2352 by 1568 pixels
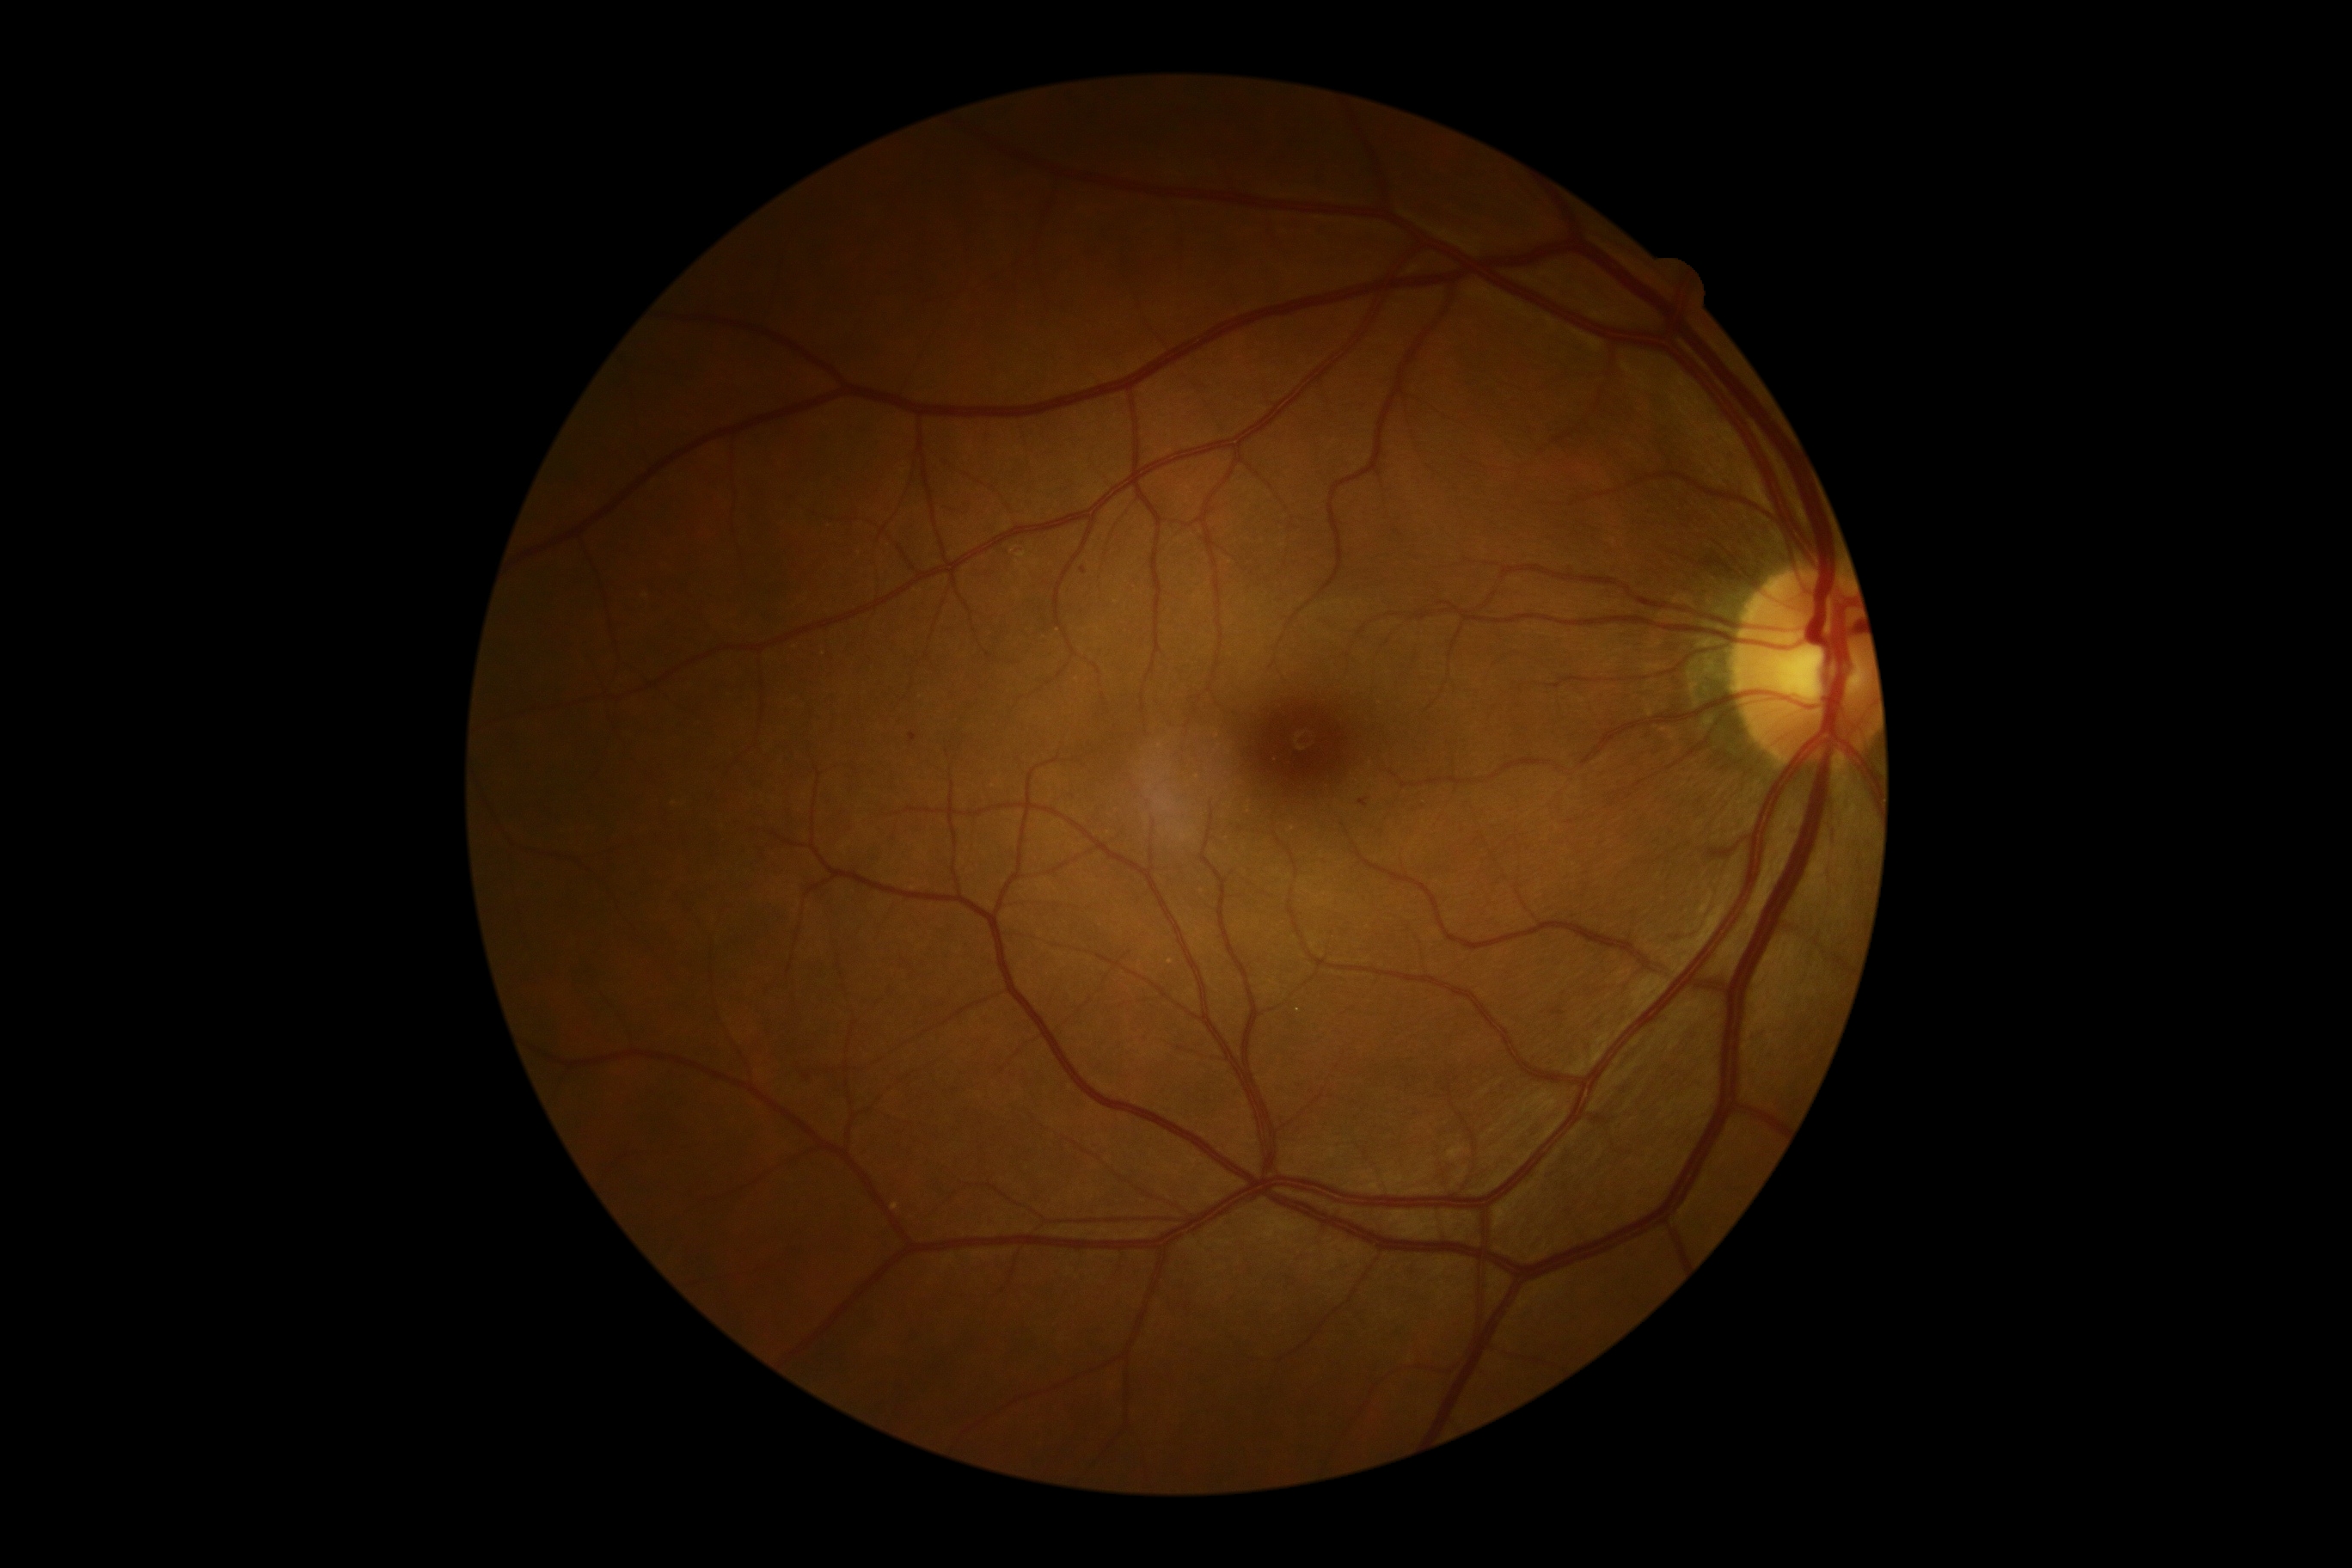

{"dr_grade": "grade 1"}